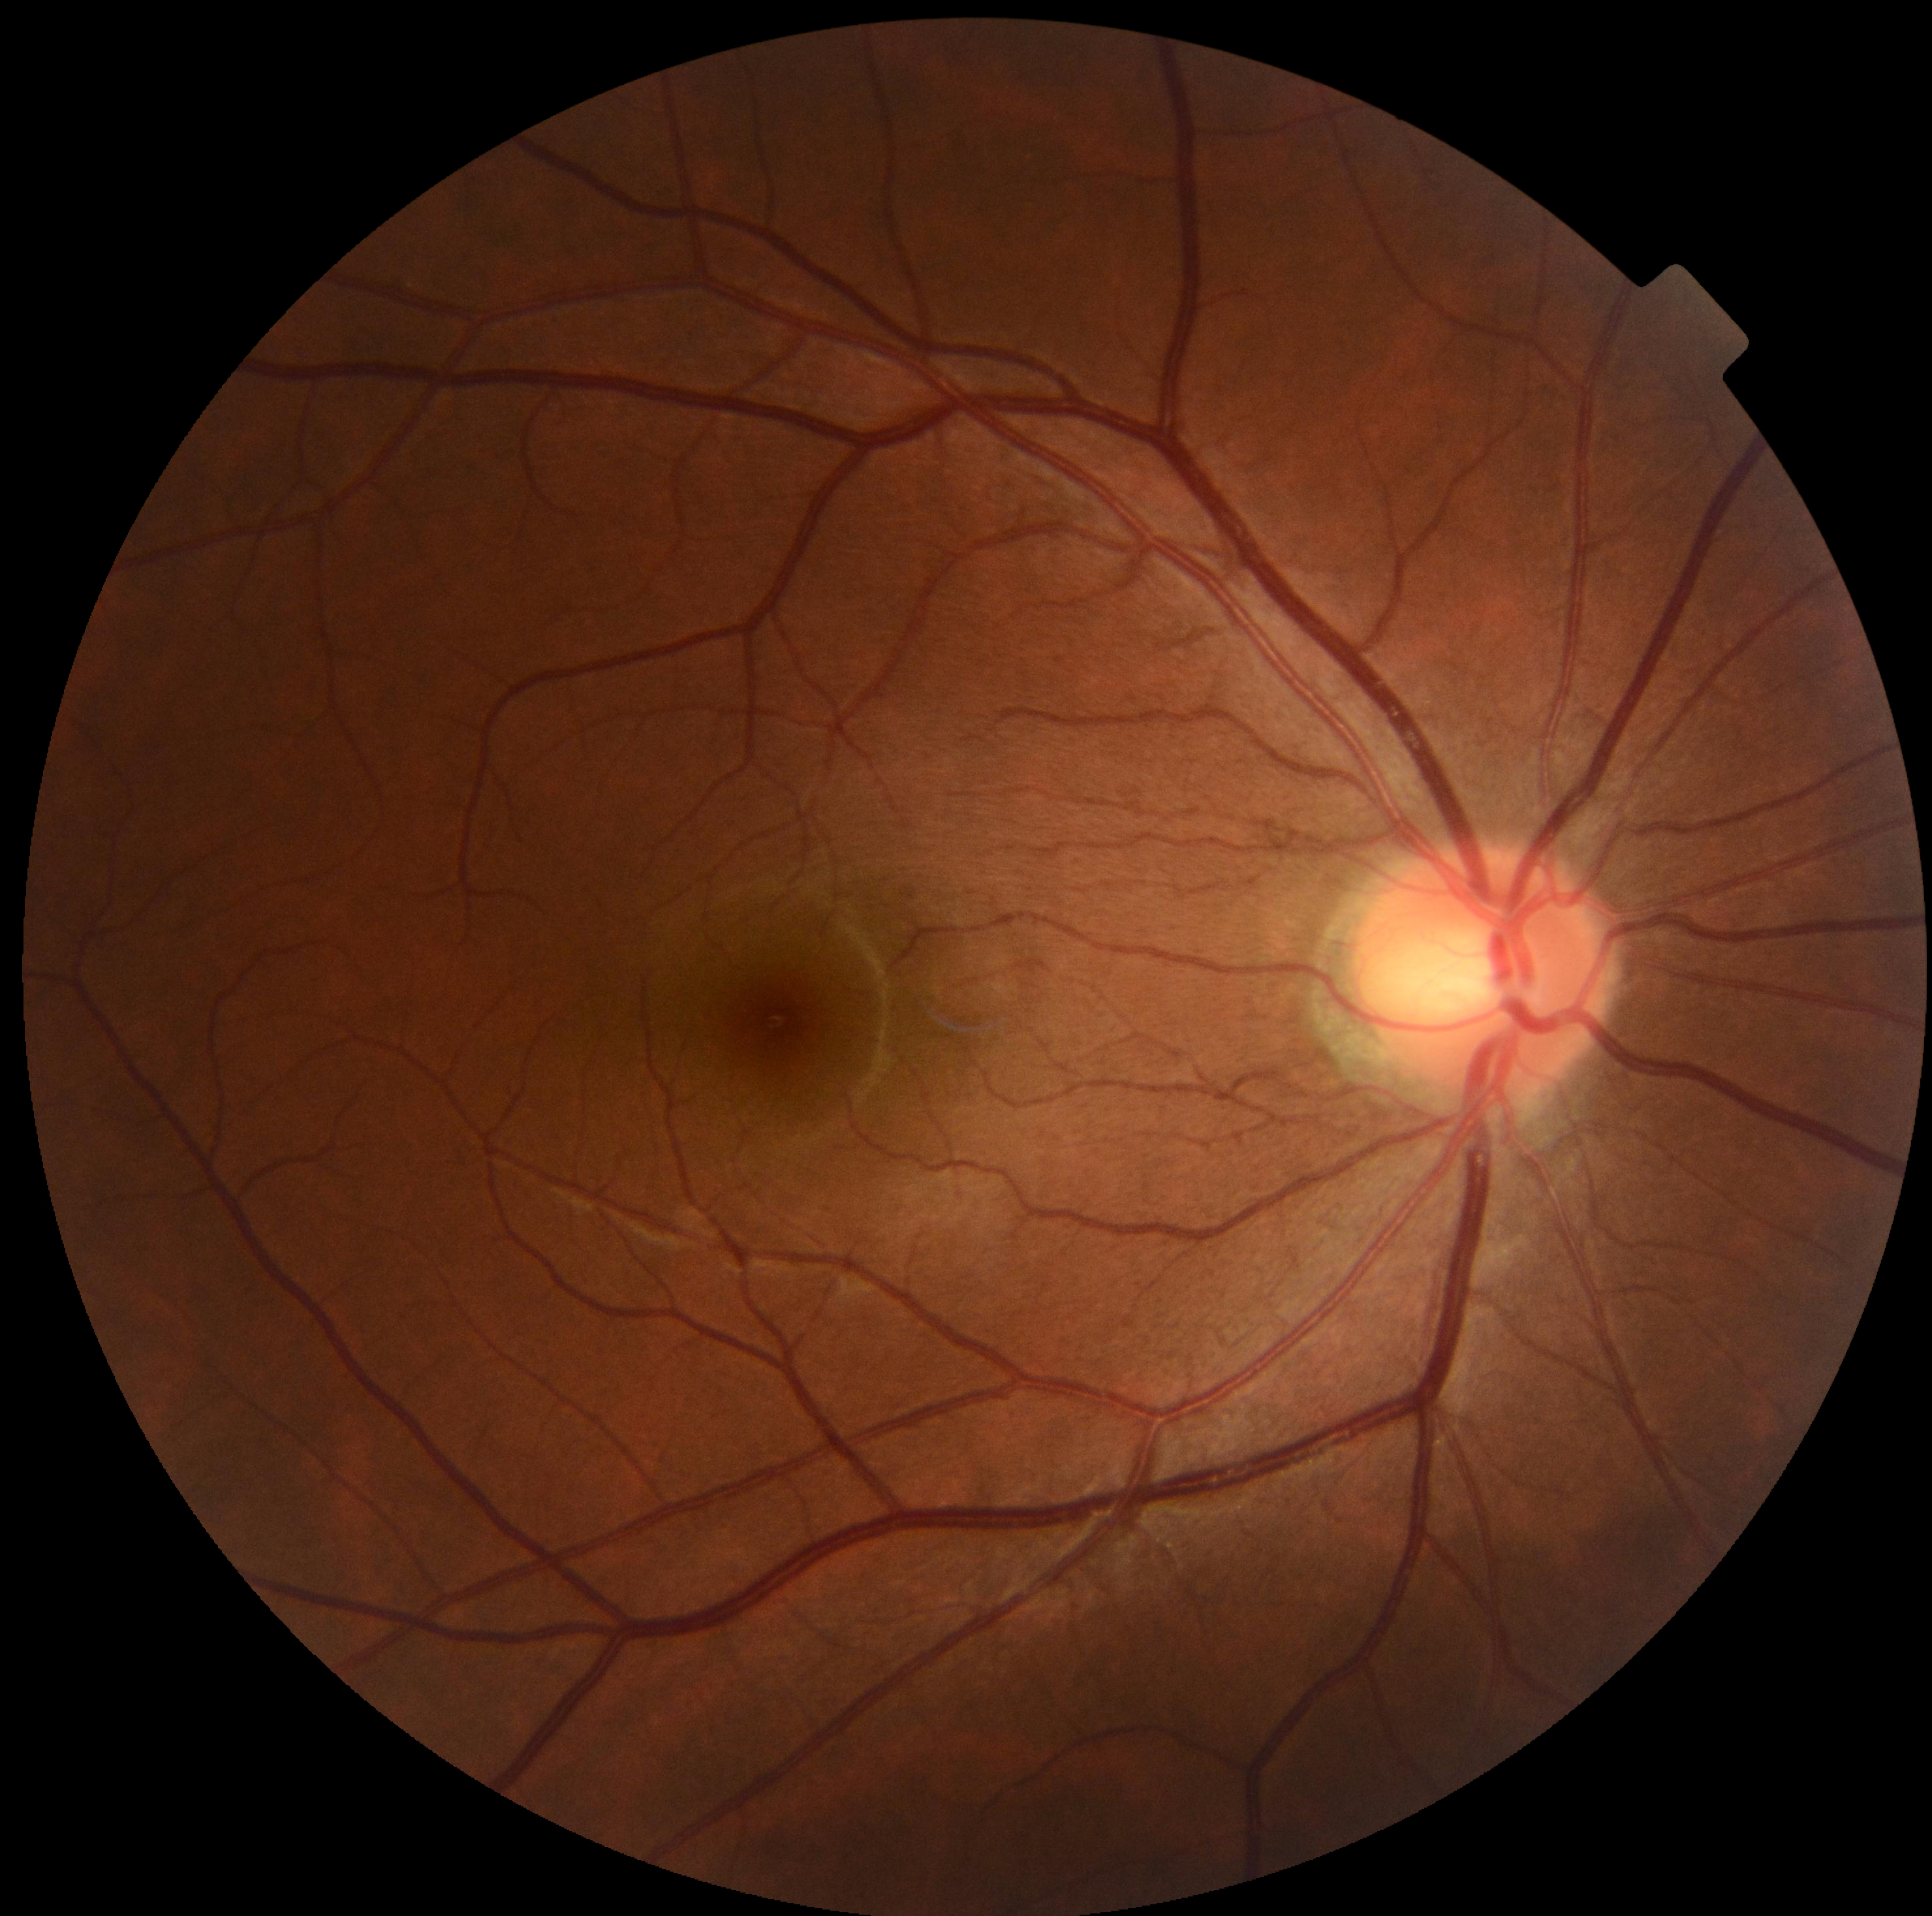
diabetic retinopathy (DR)=no apparent retinopathy (grade 0).